Macula at the center of the field: 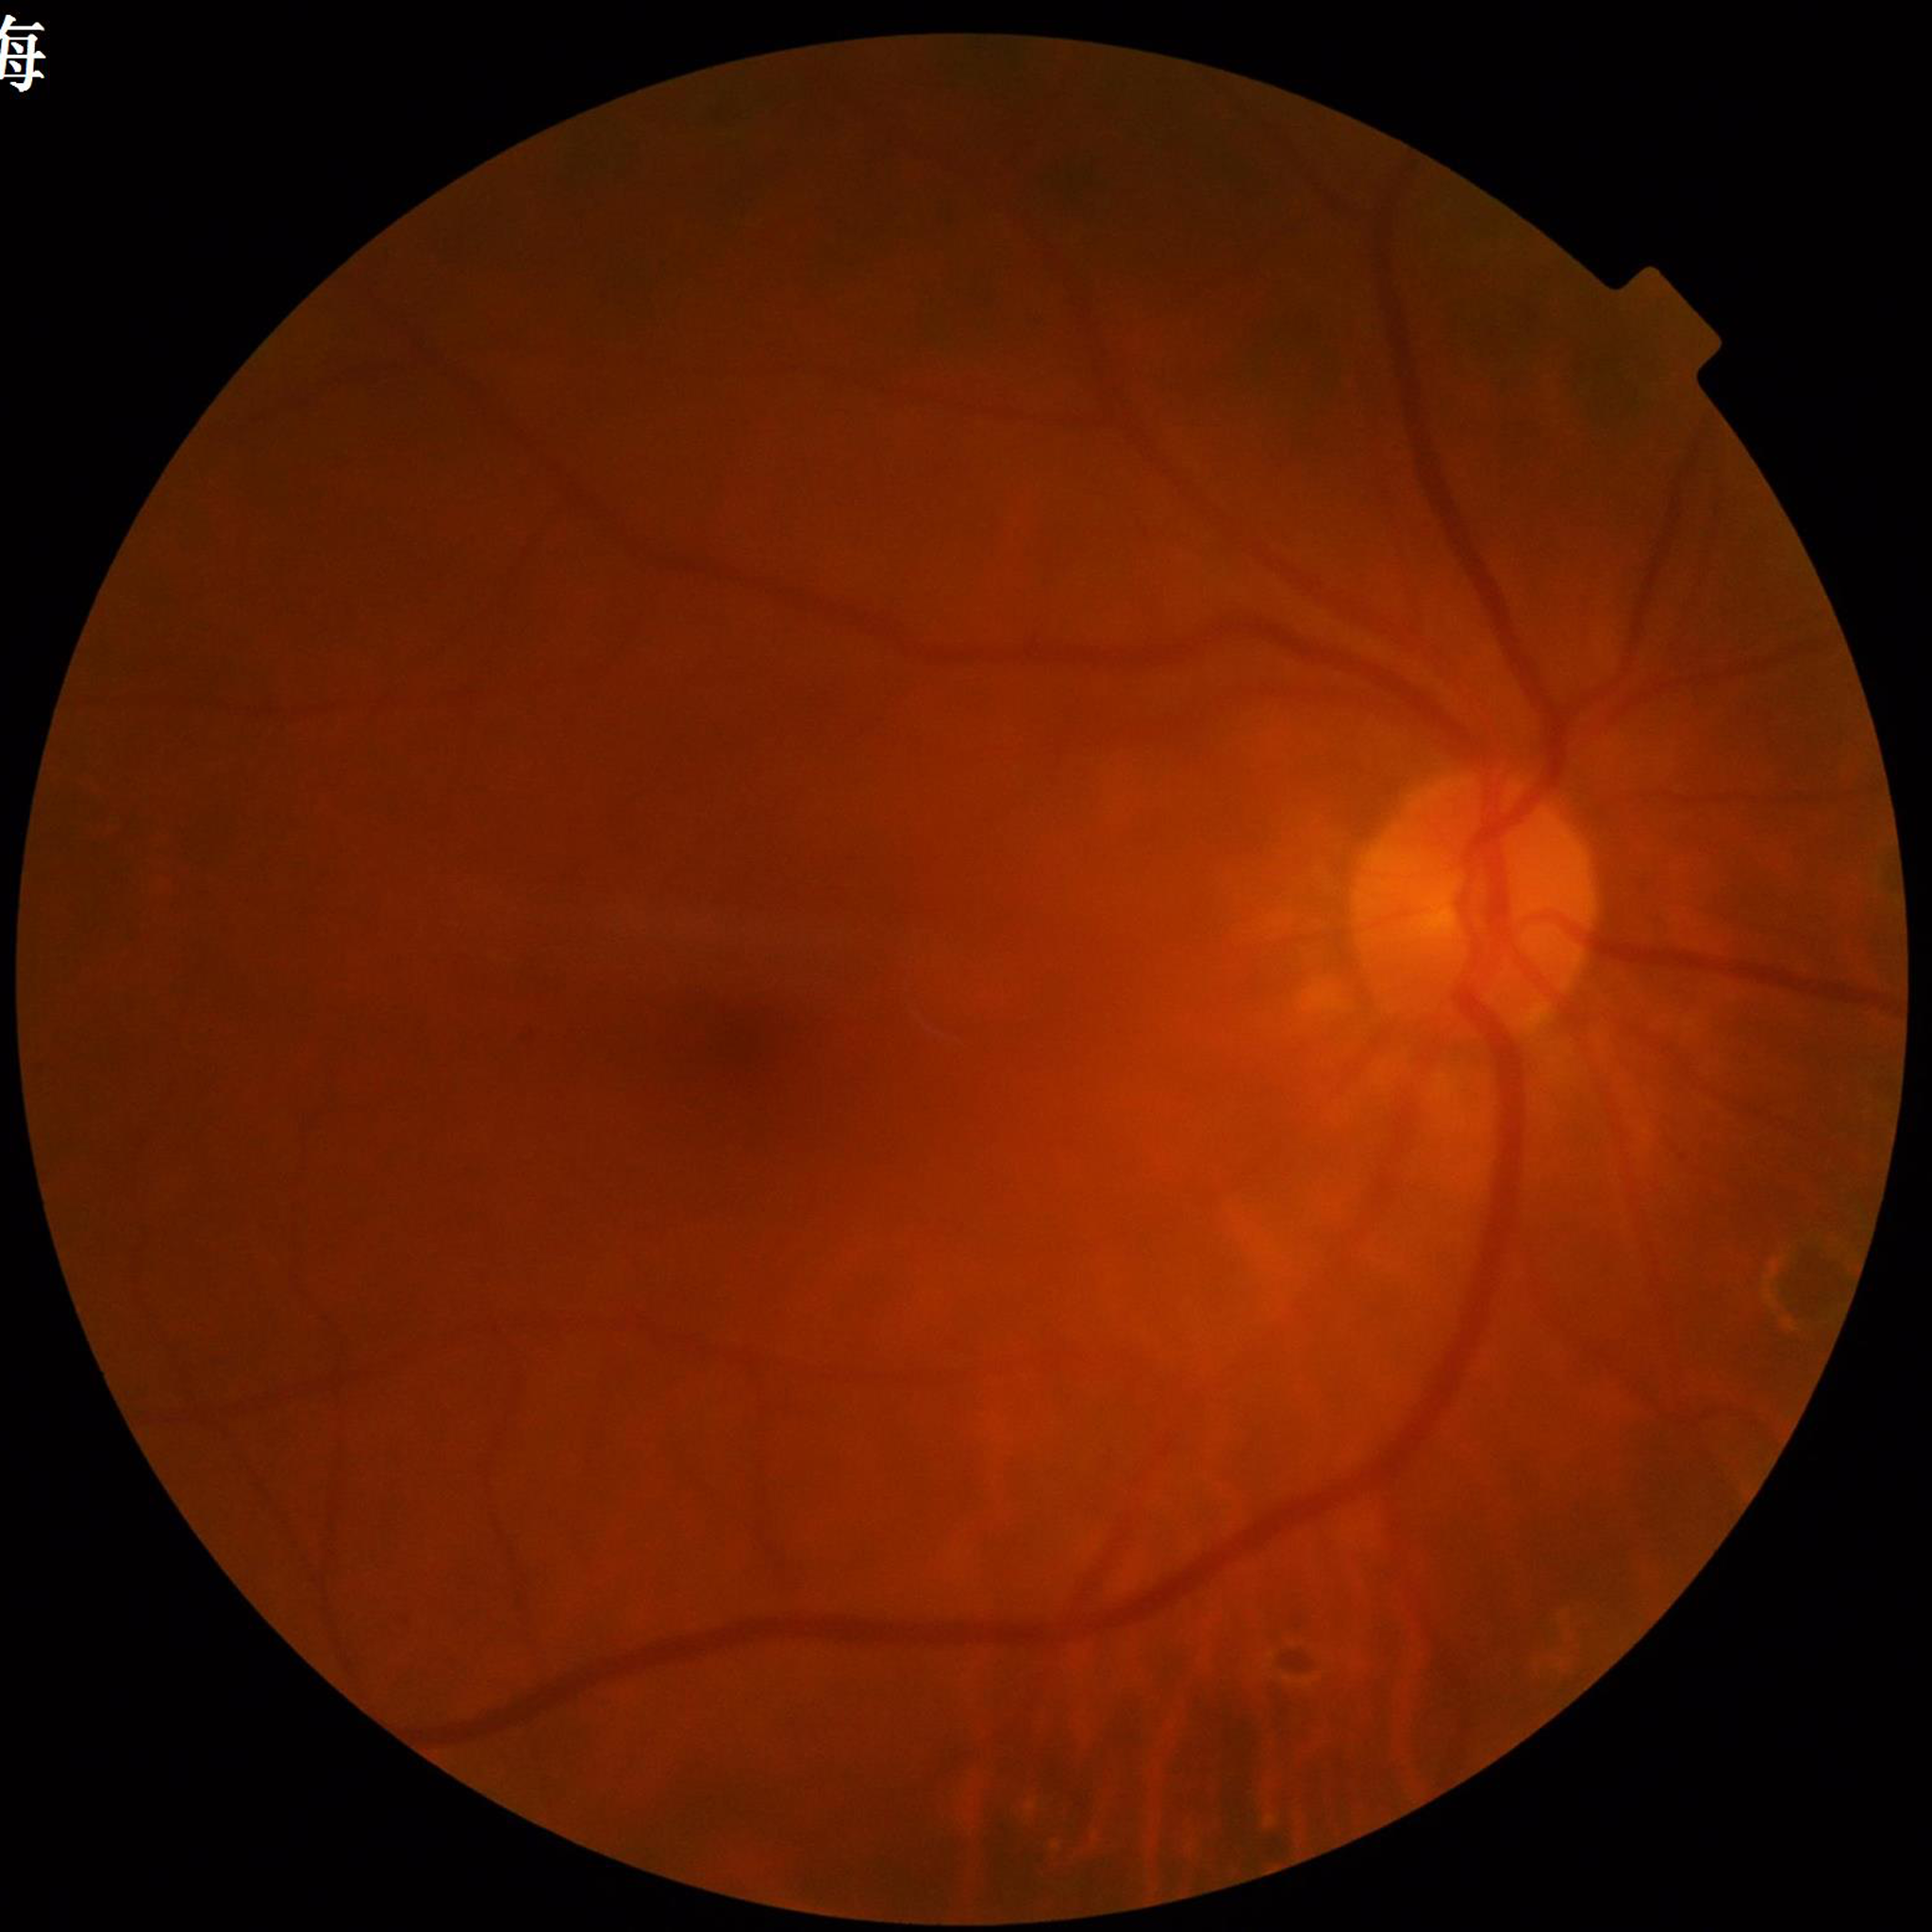 Diagnosed with diabetic retinopathy.